45° field of view — 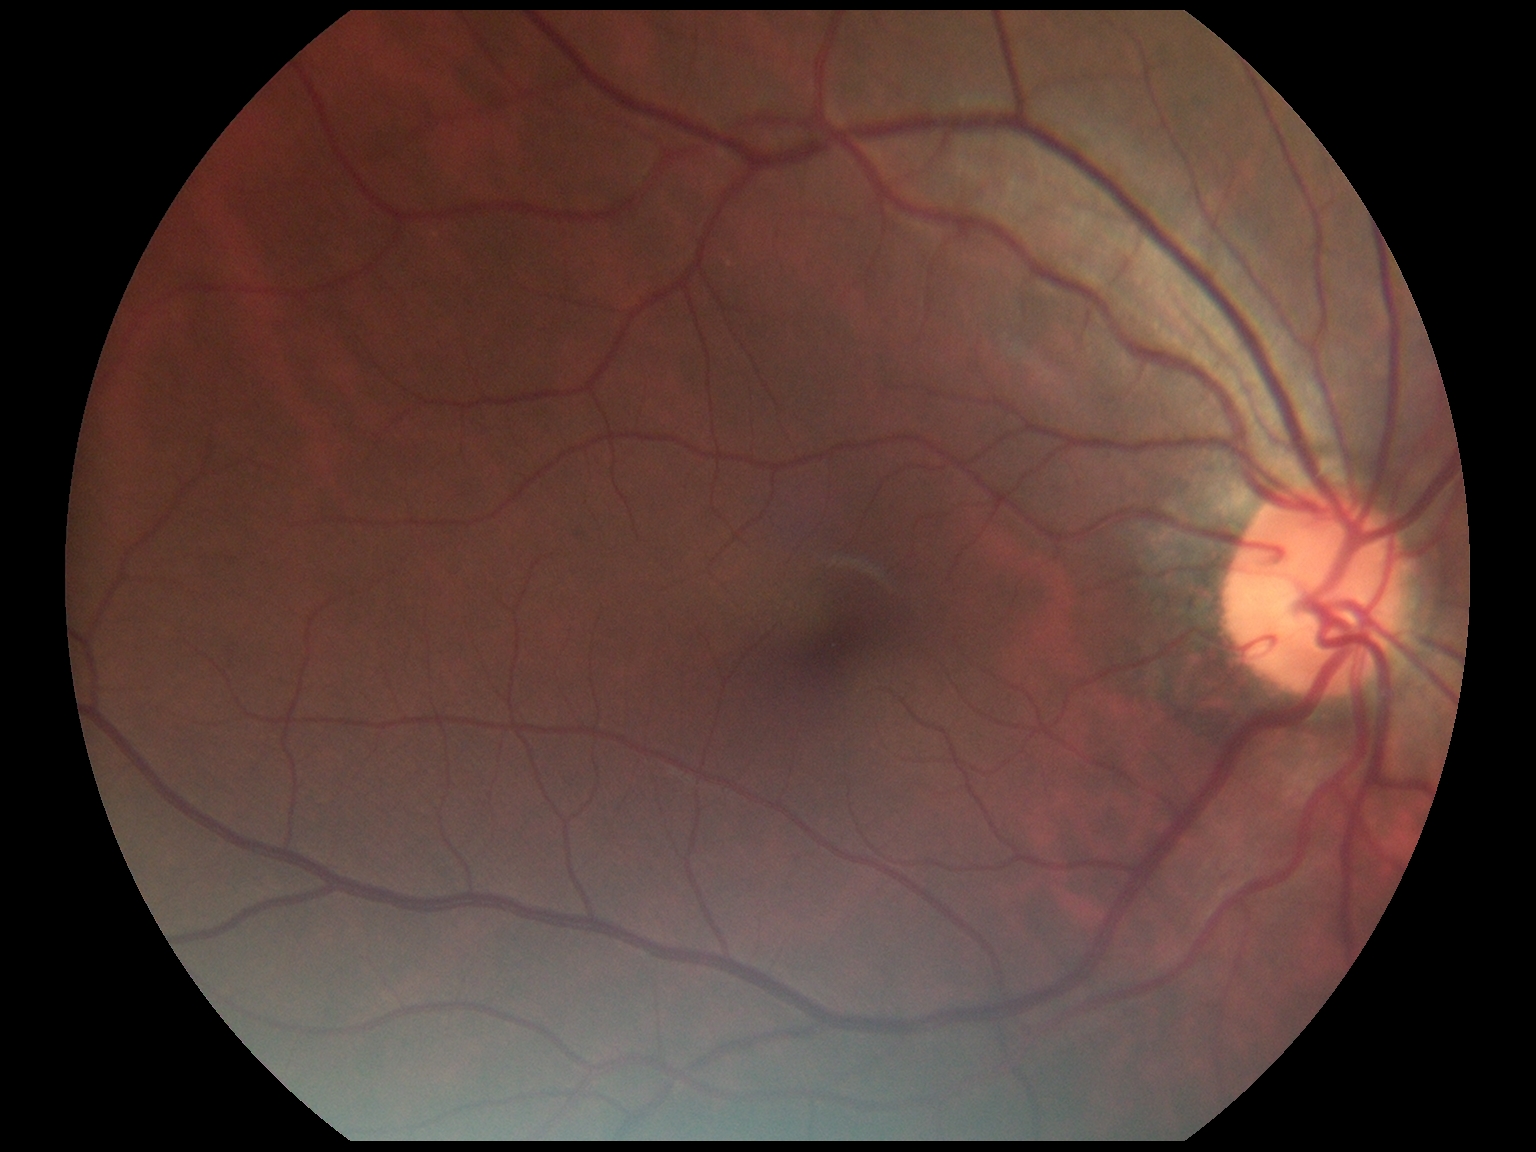

retinopathy@grade 0.